Color fundus photograph, 45° field of view, 2352 x 1568 pixels — 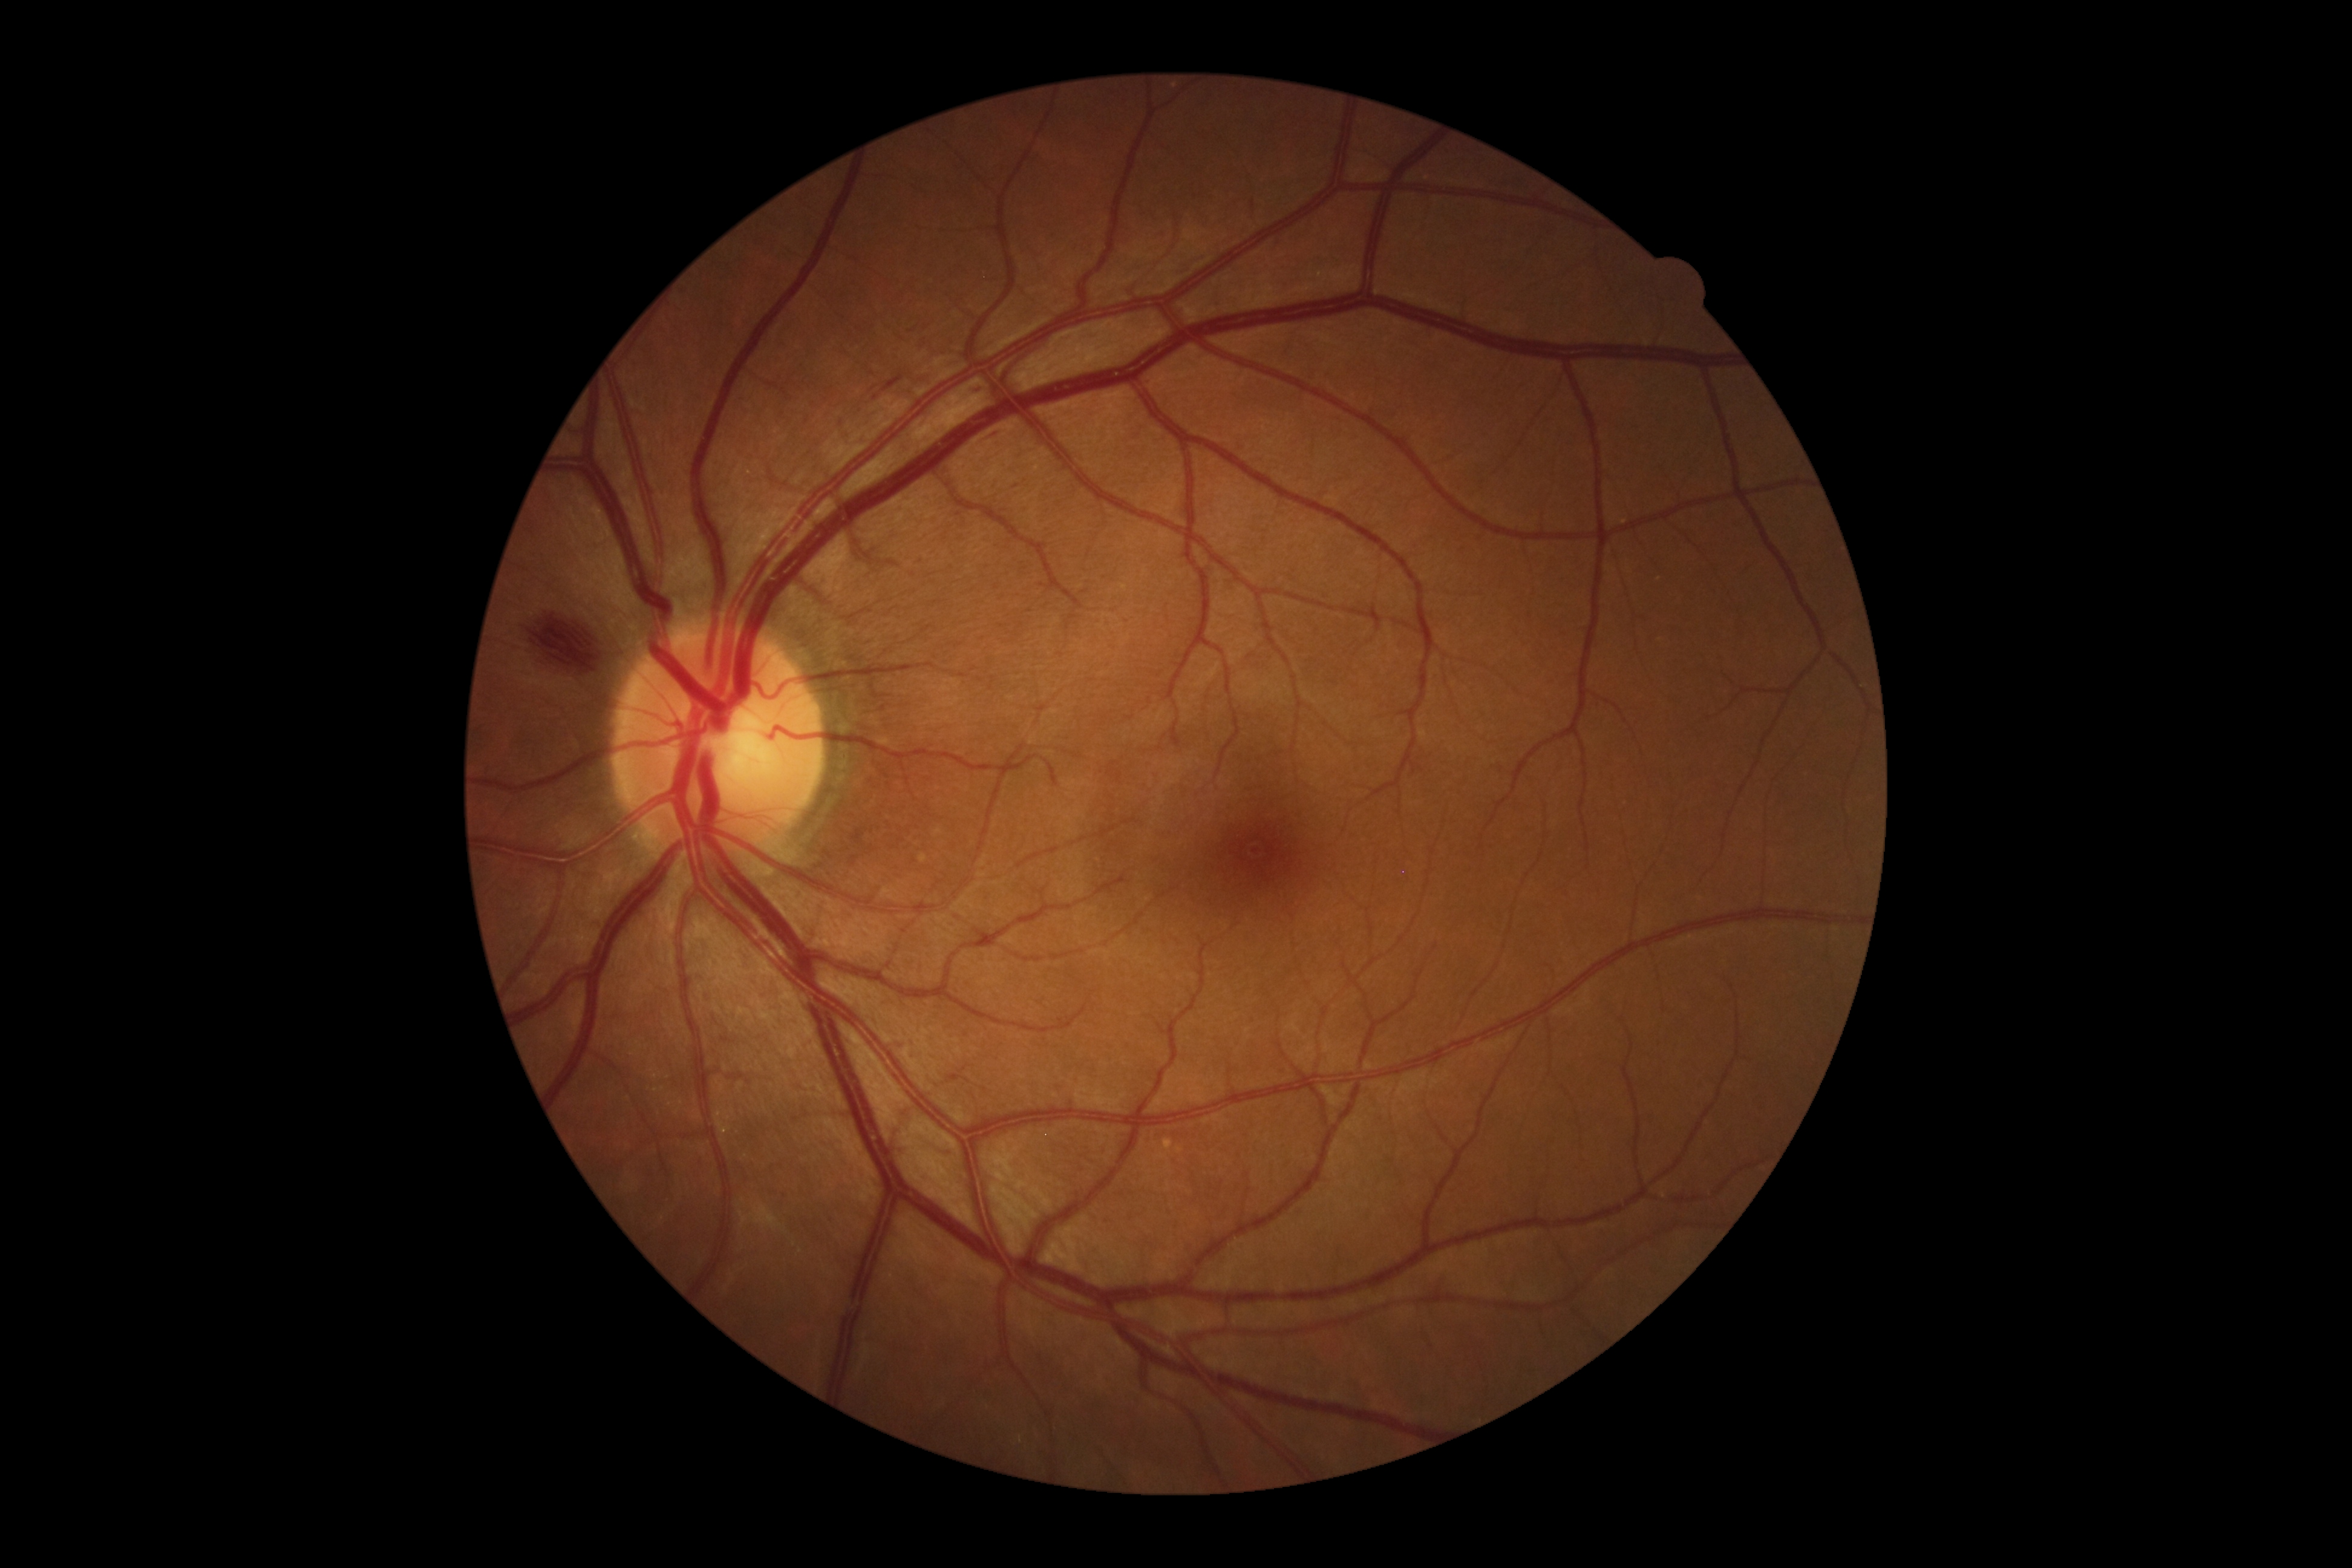 Diabetic retinopathy (DR): 2.
Disease class: non-proliferative diabetic retinopathy.